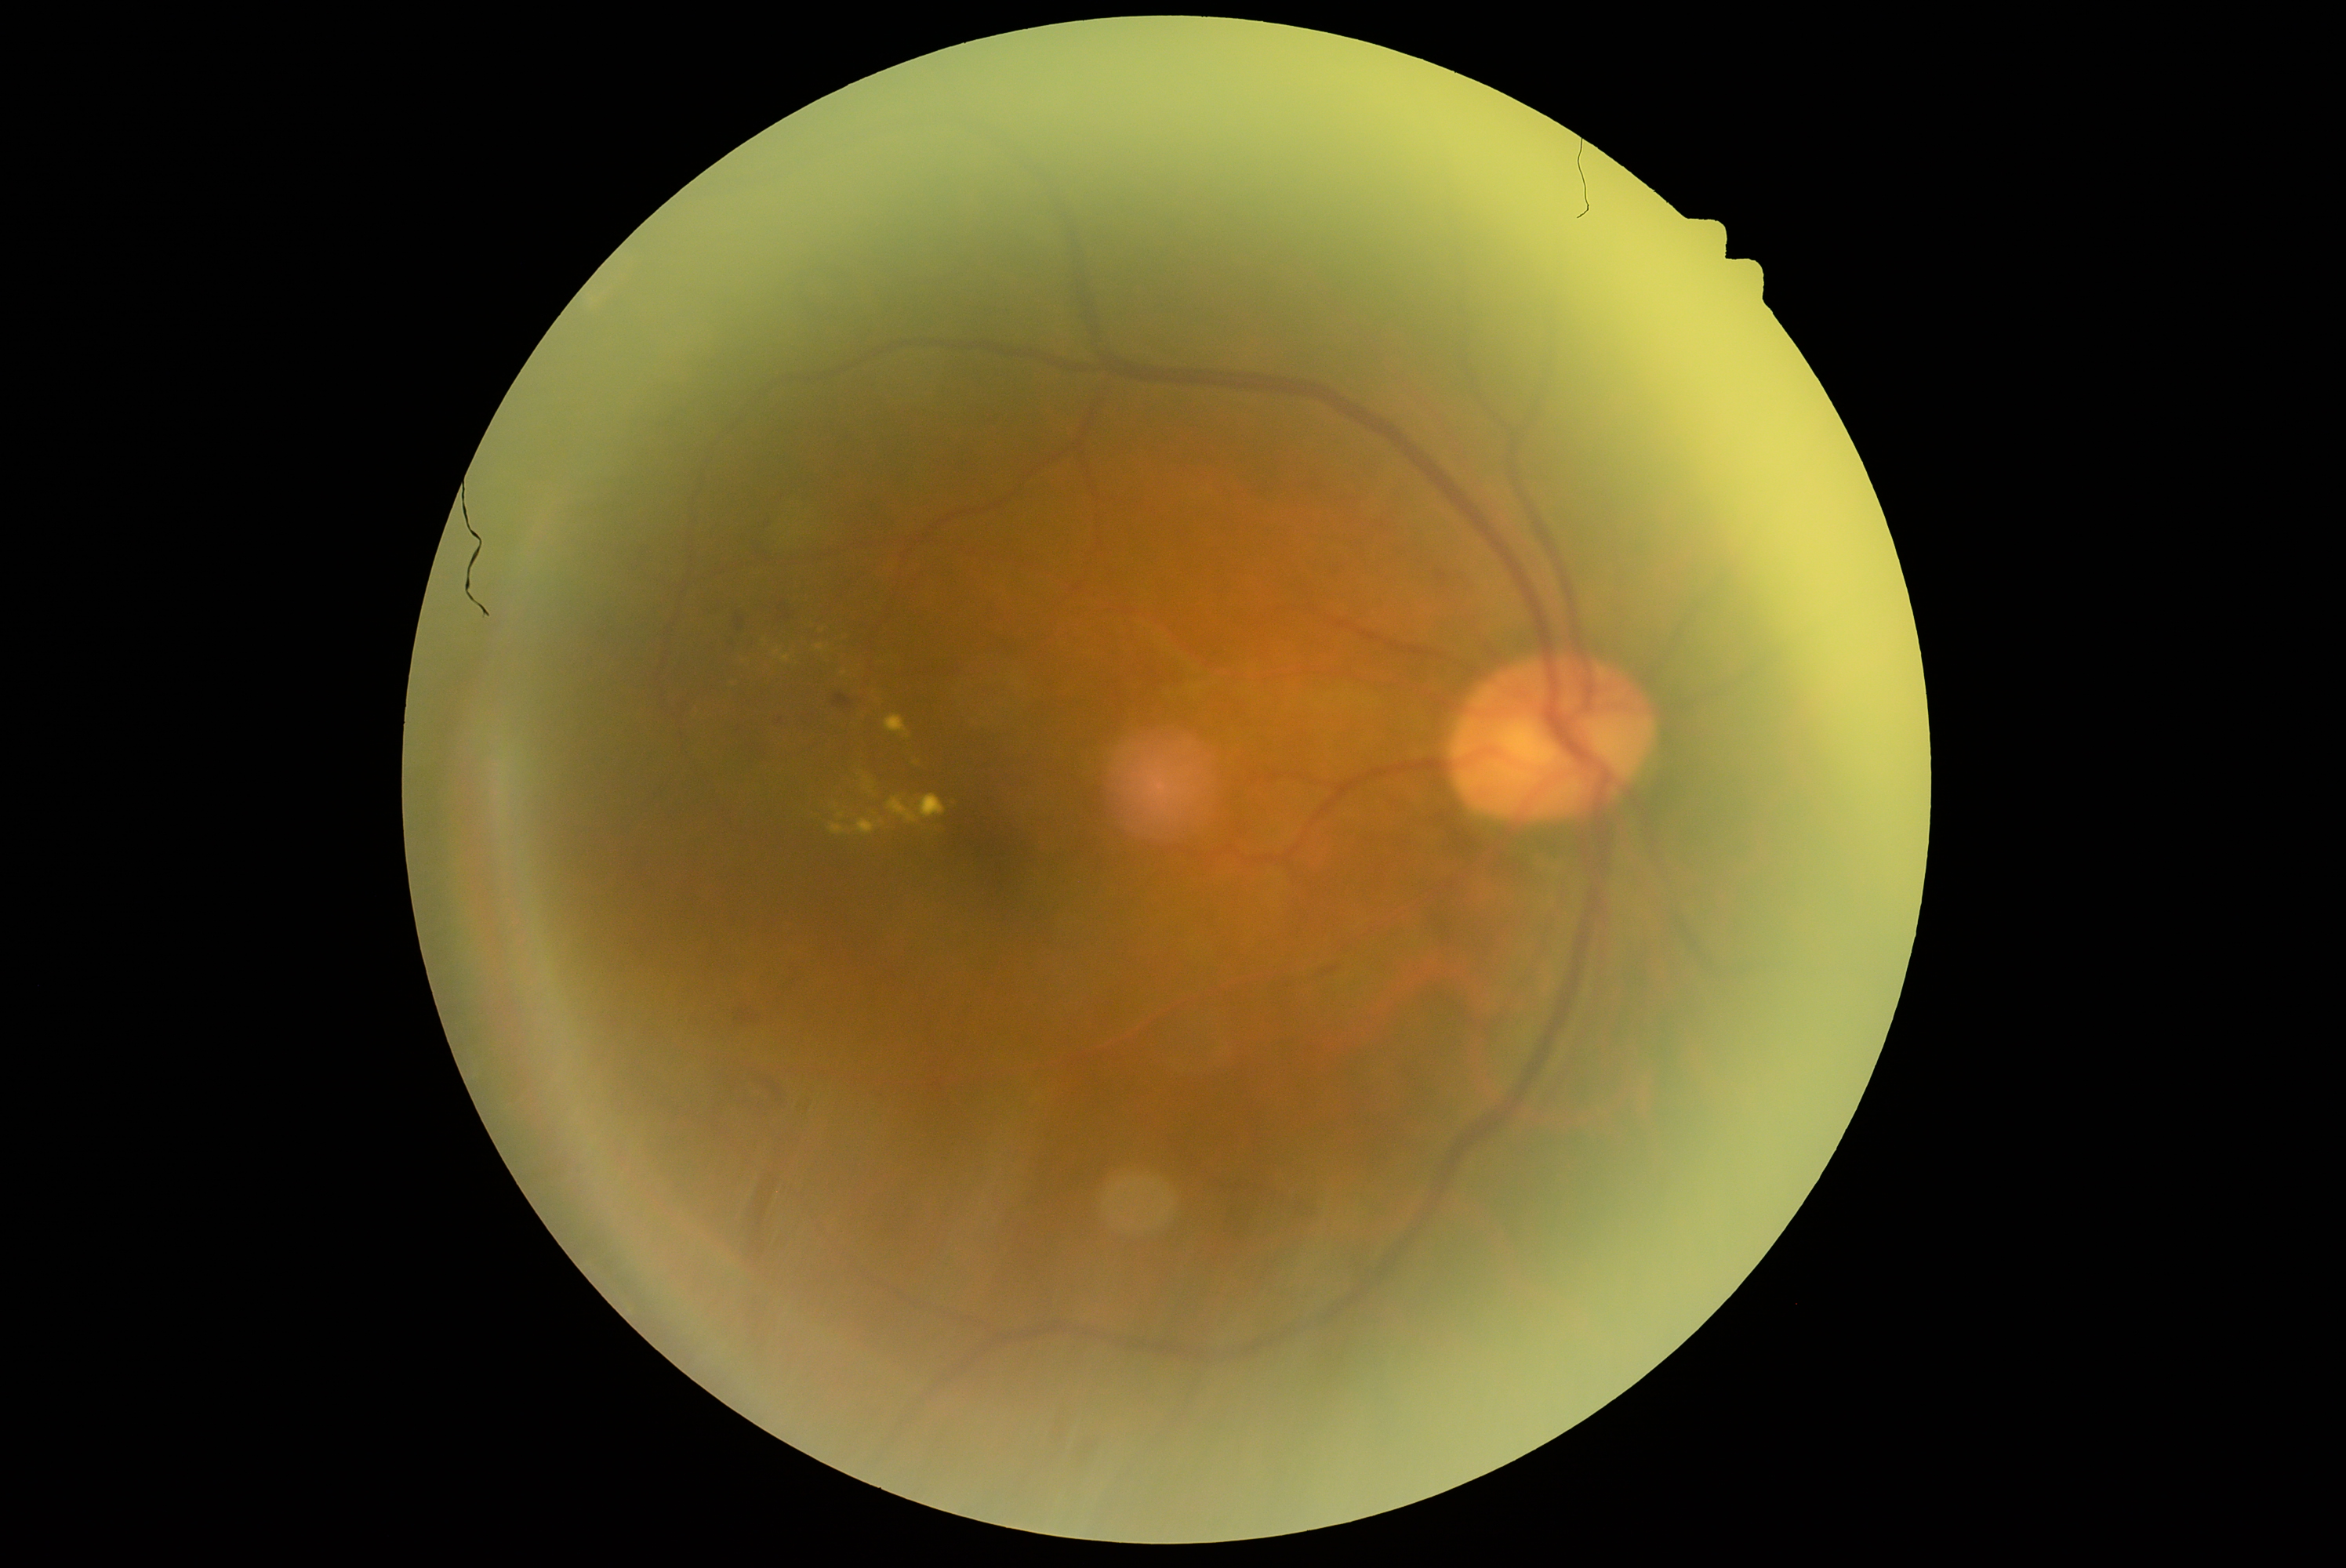 Diabetic retinopathy (DR) is moderate NPDR (grade 2).